1659x2212.
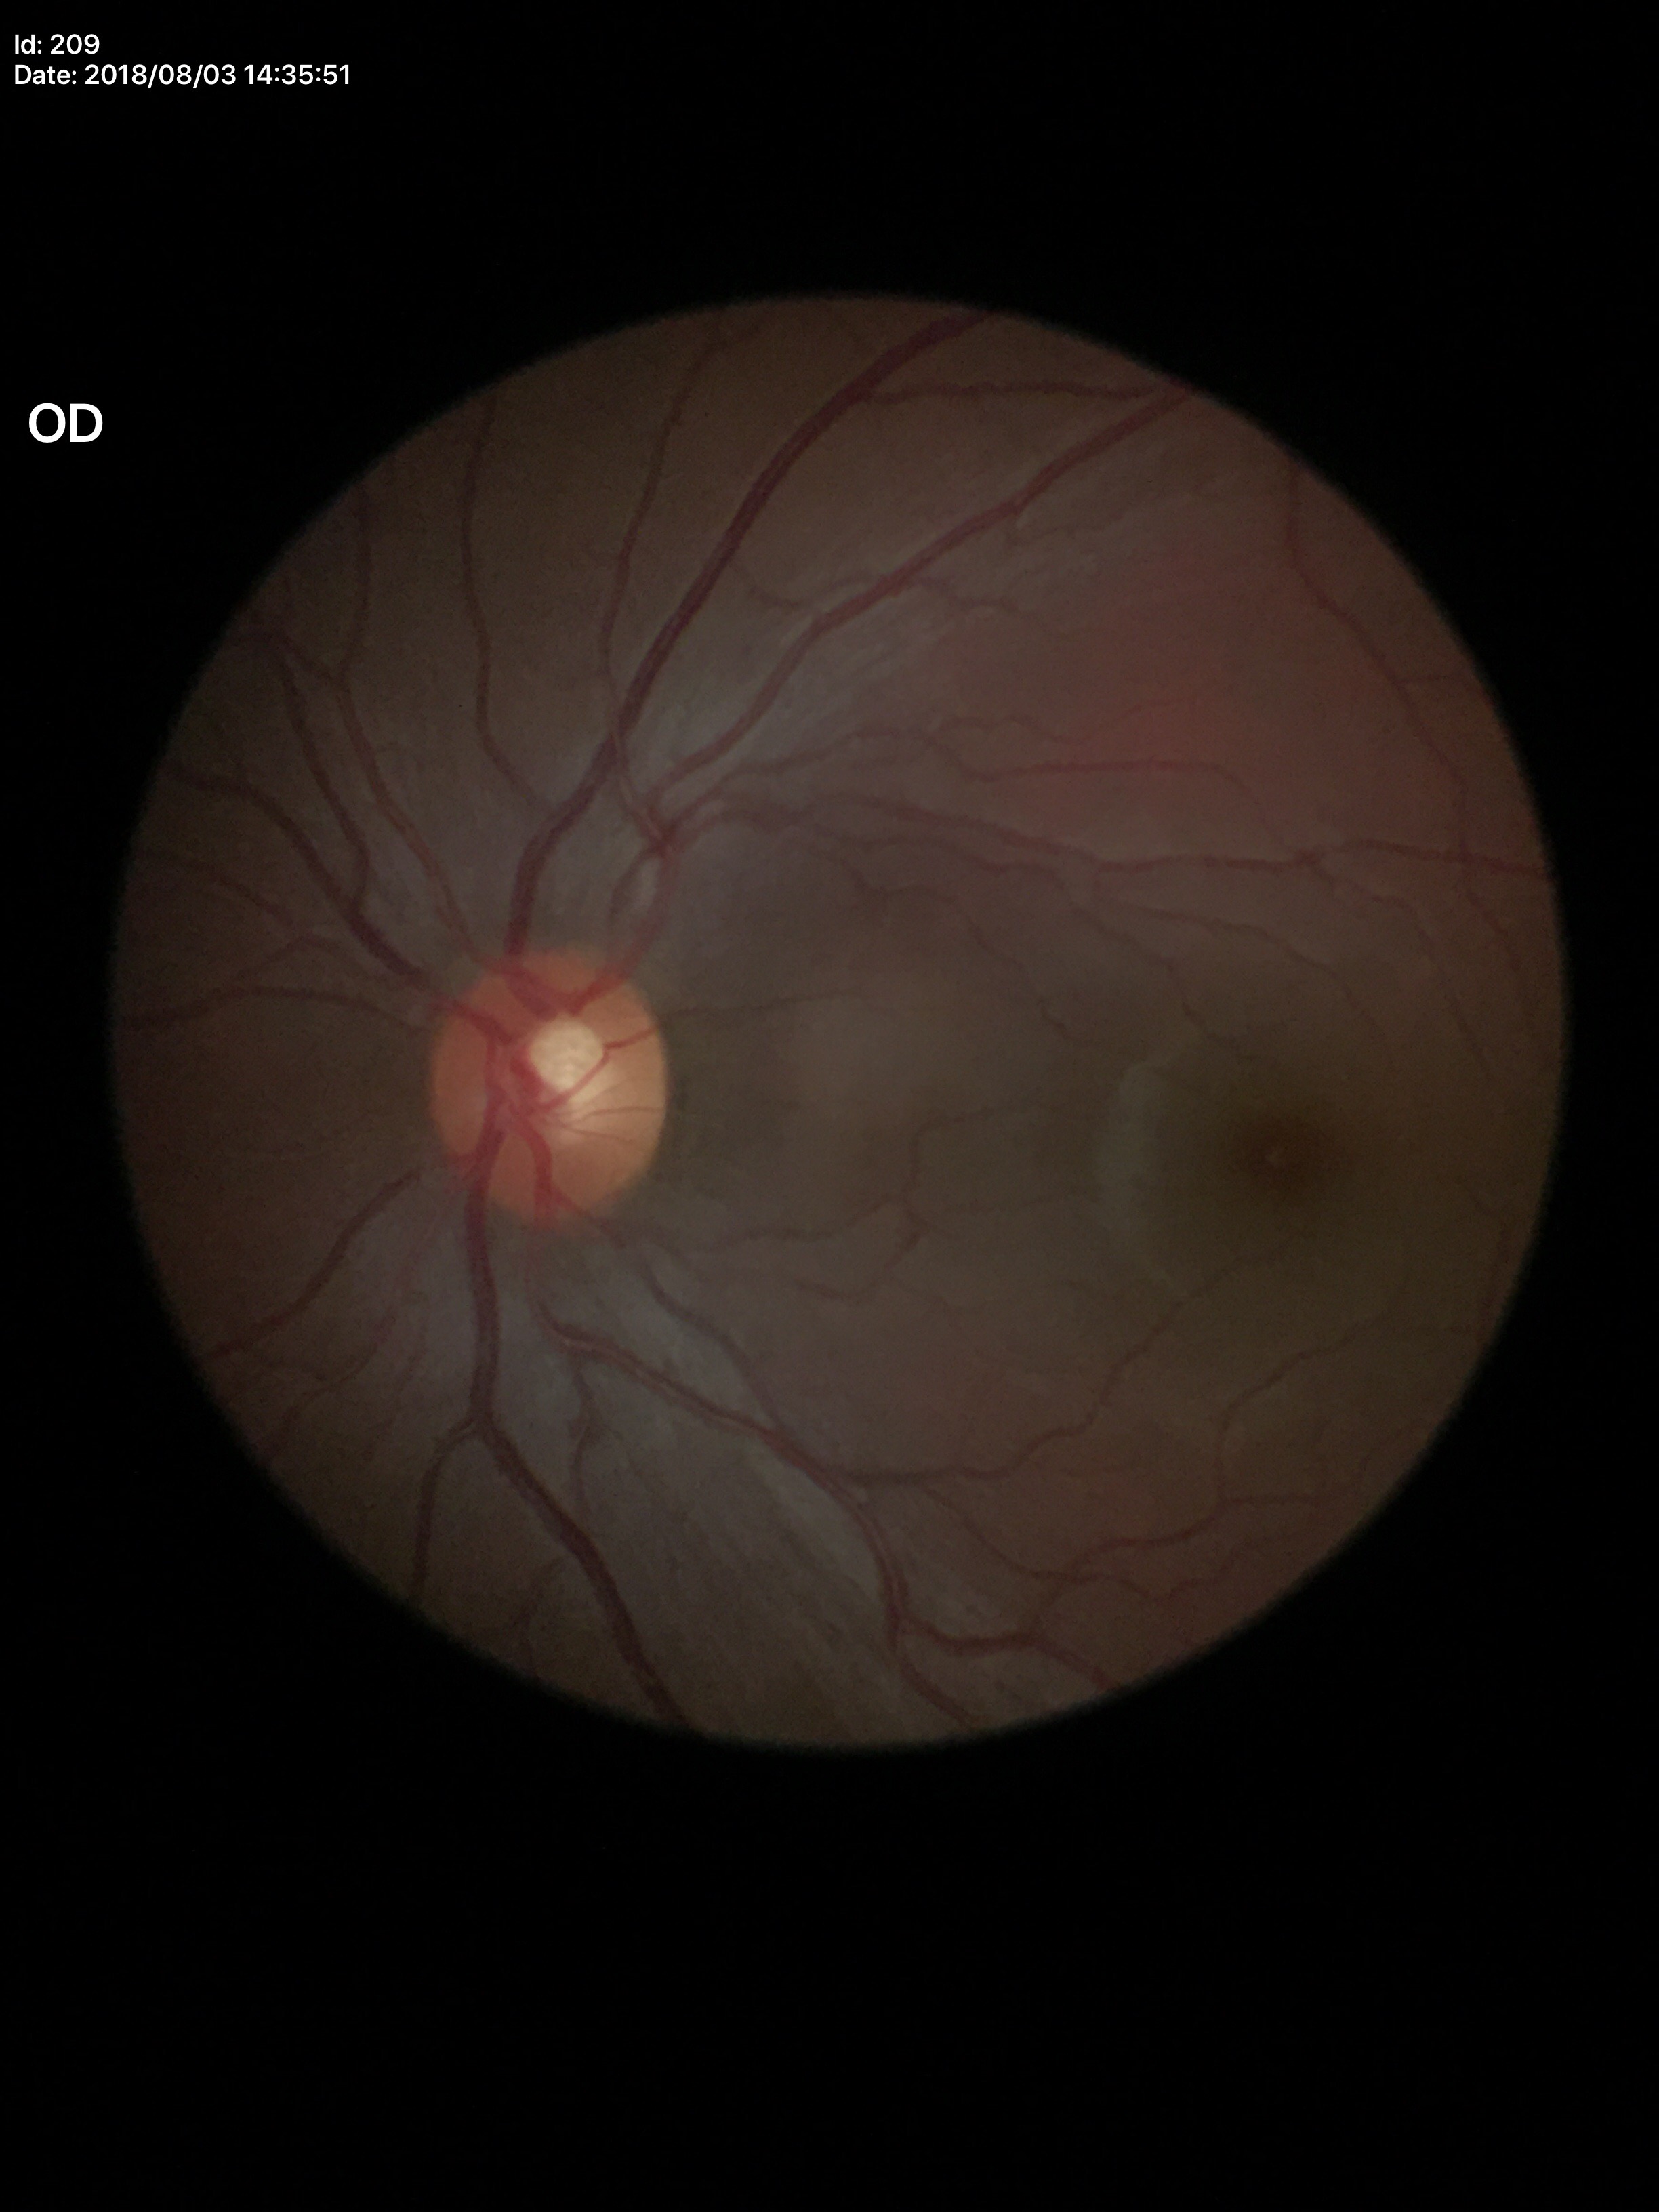

Glaucoma screening = not suspect | vertical cup-to-disc ratio = 0.48 | horizontal cup-to-disc ratio = 0.53.